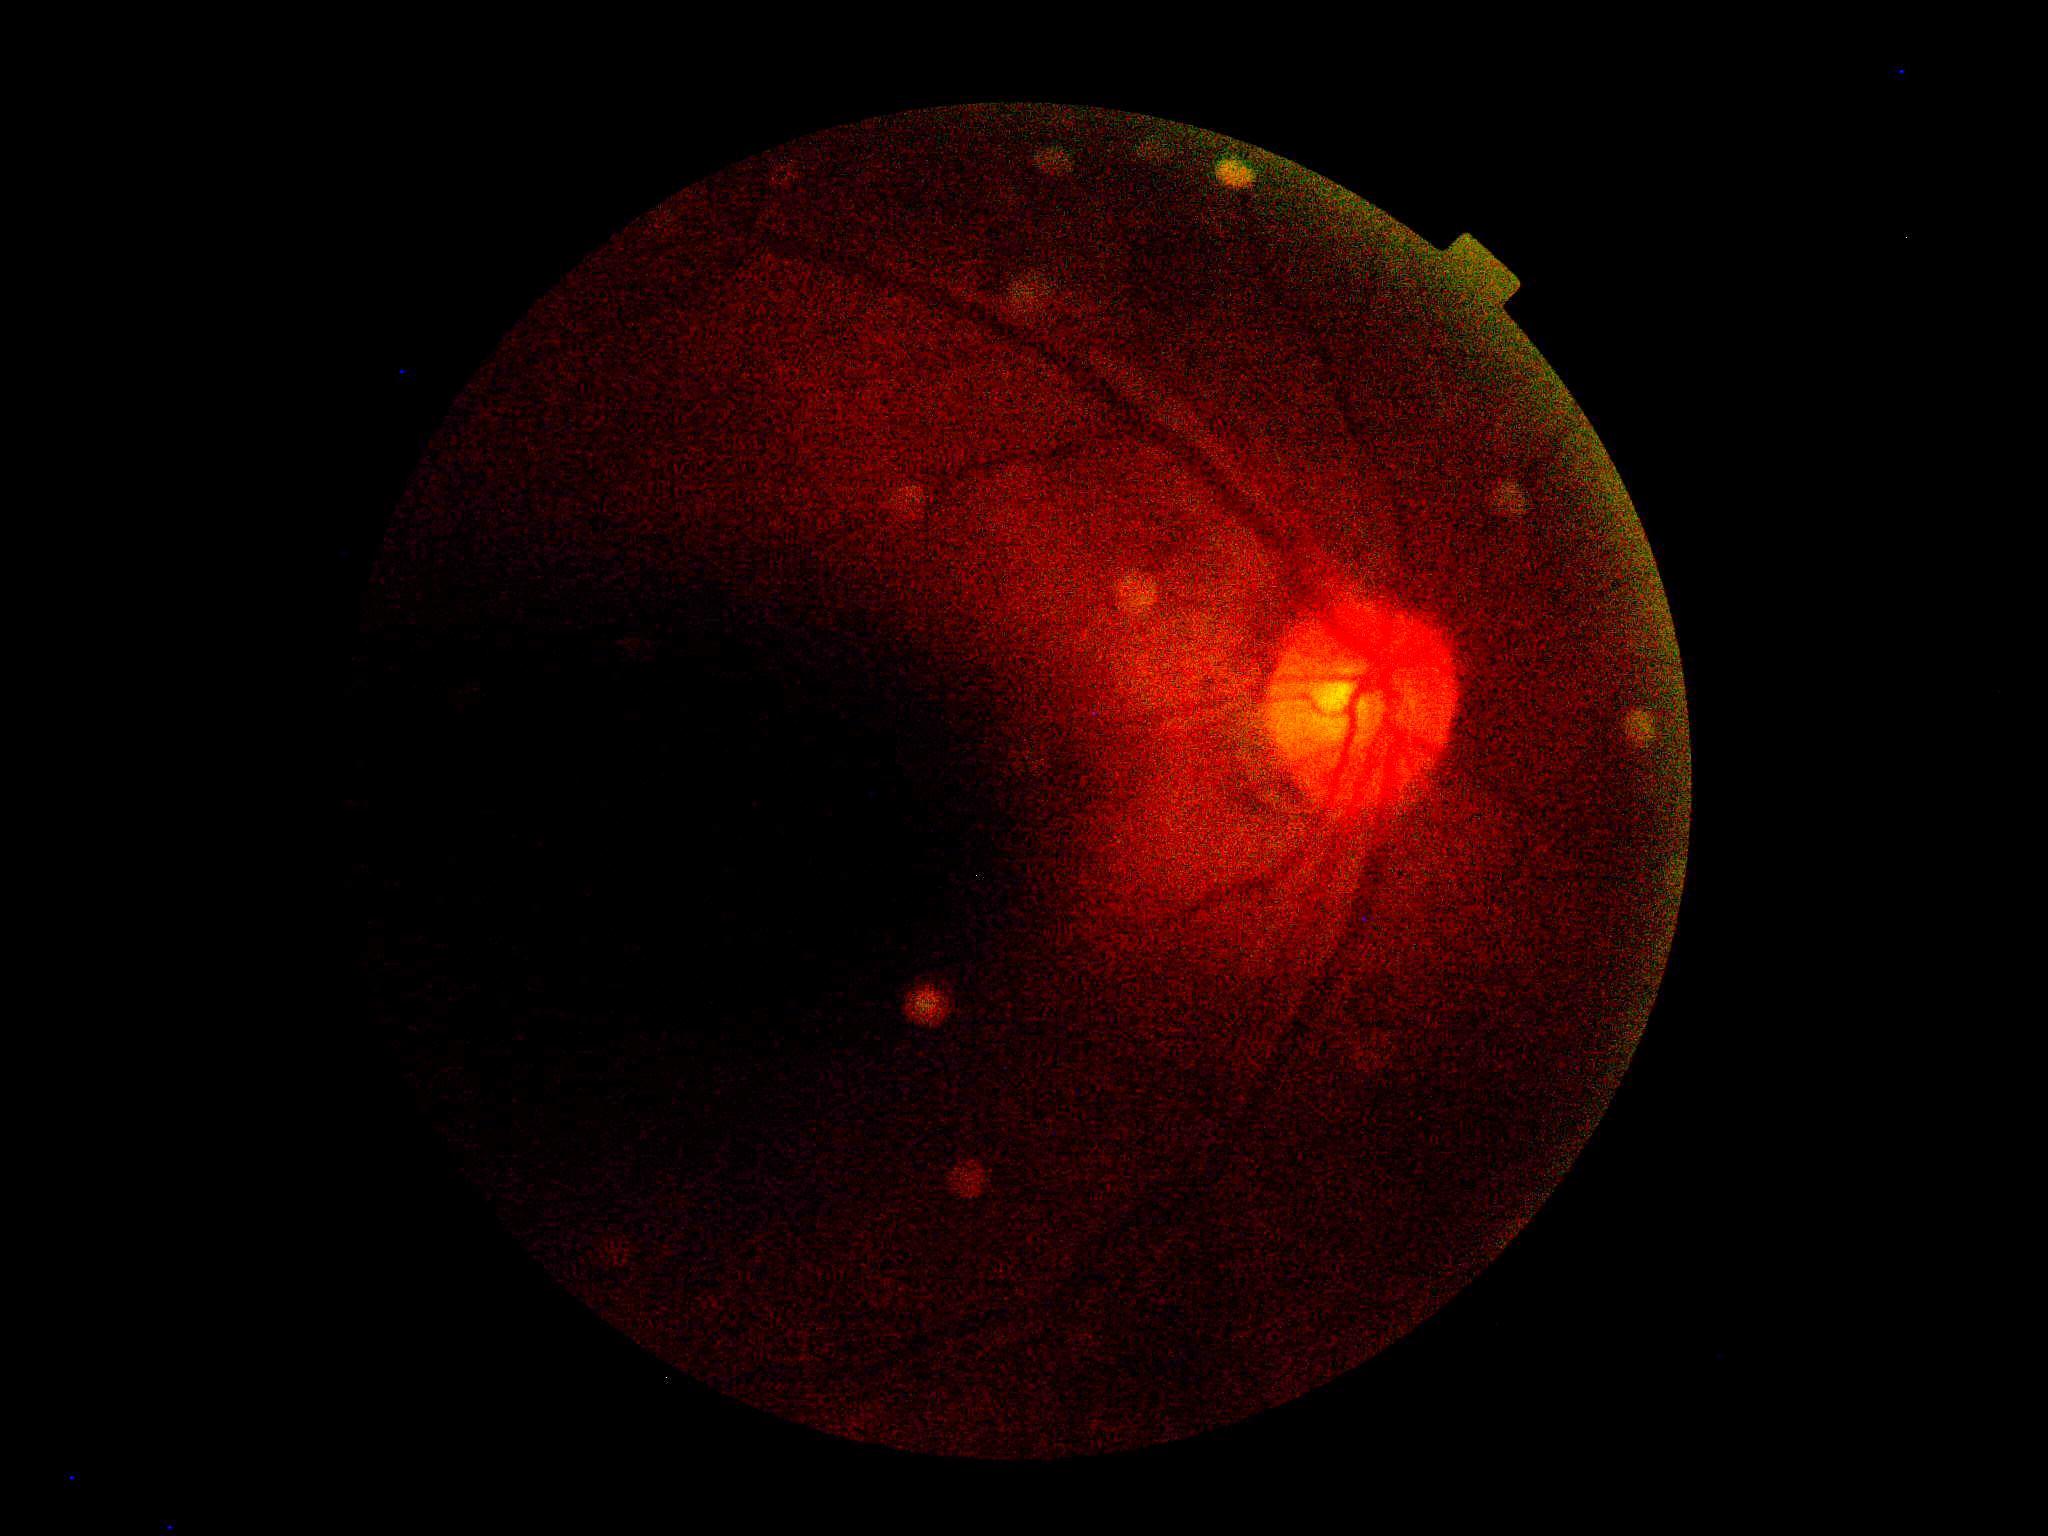 Diabetic retinopathy (DR): ungradable.